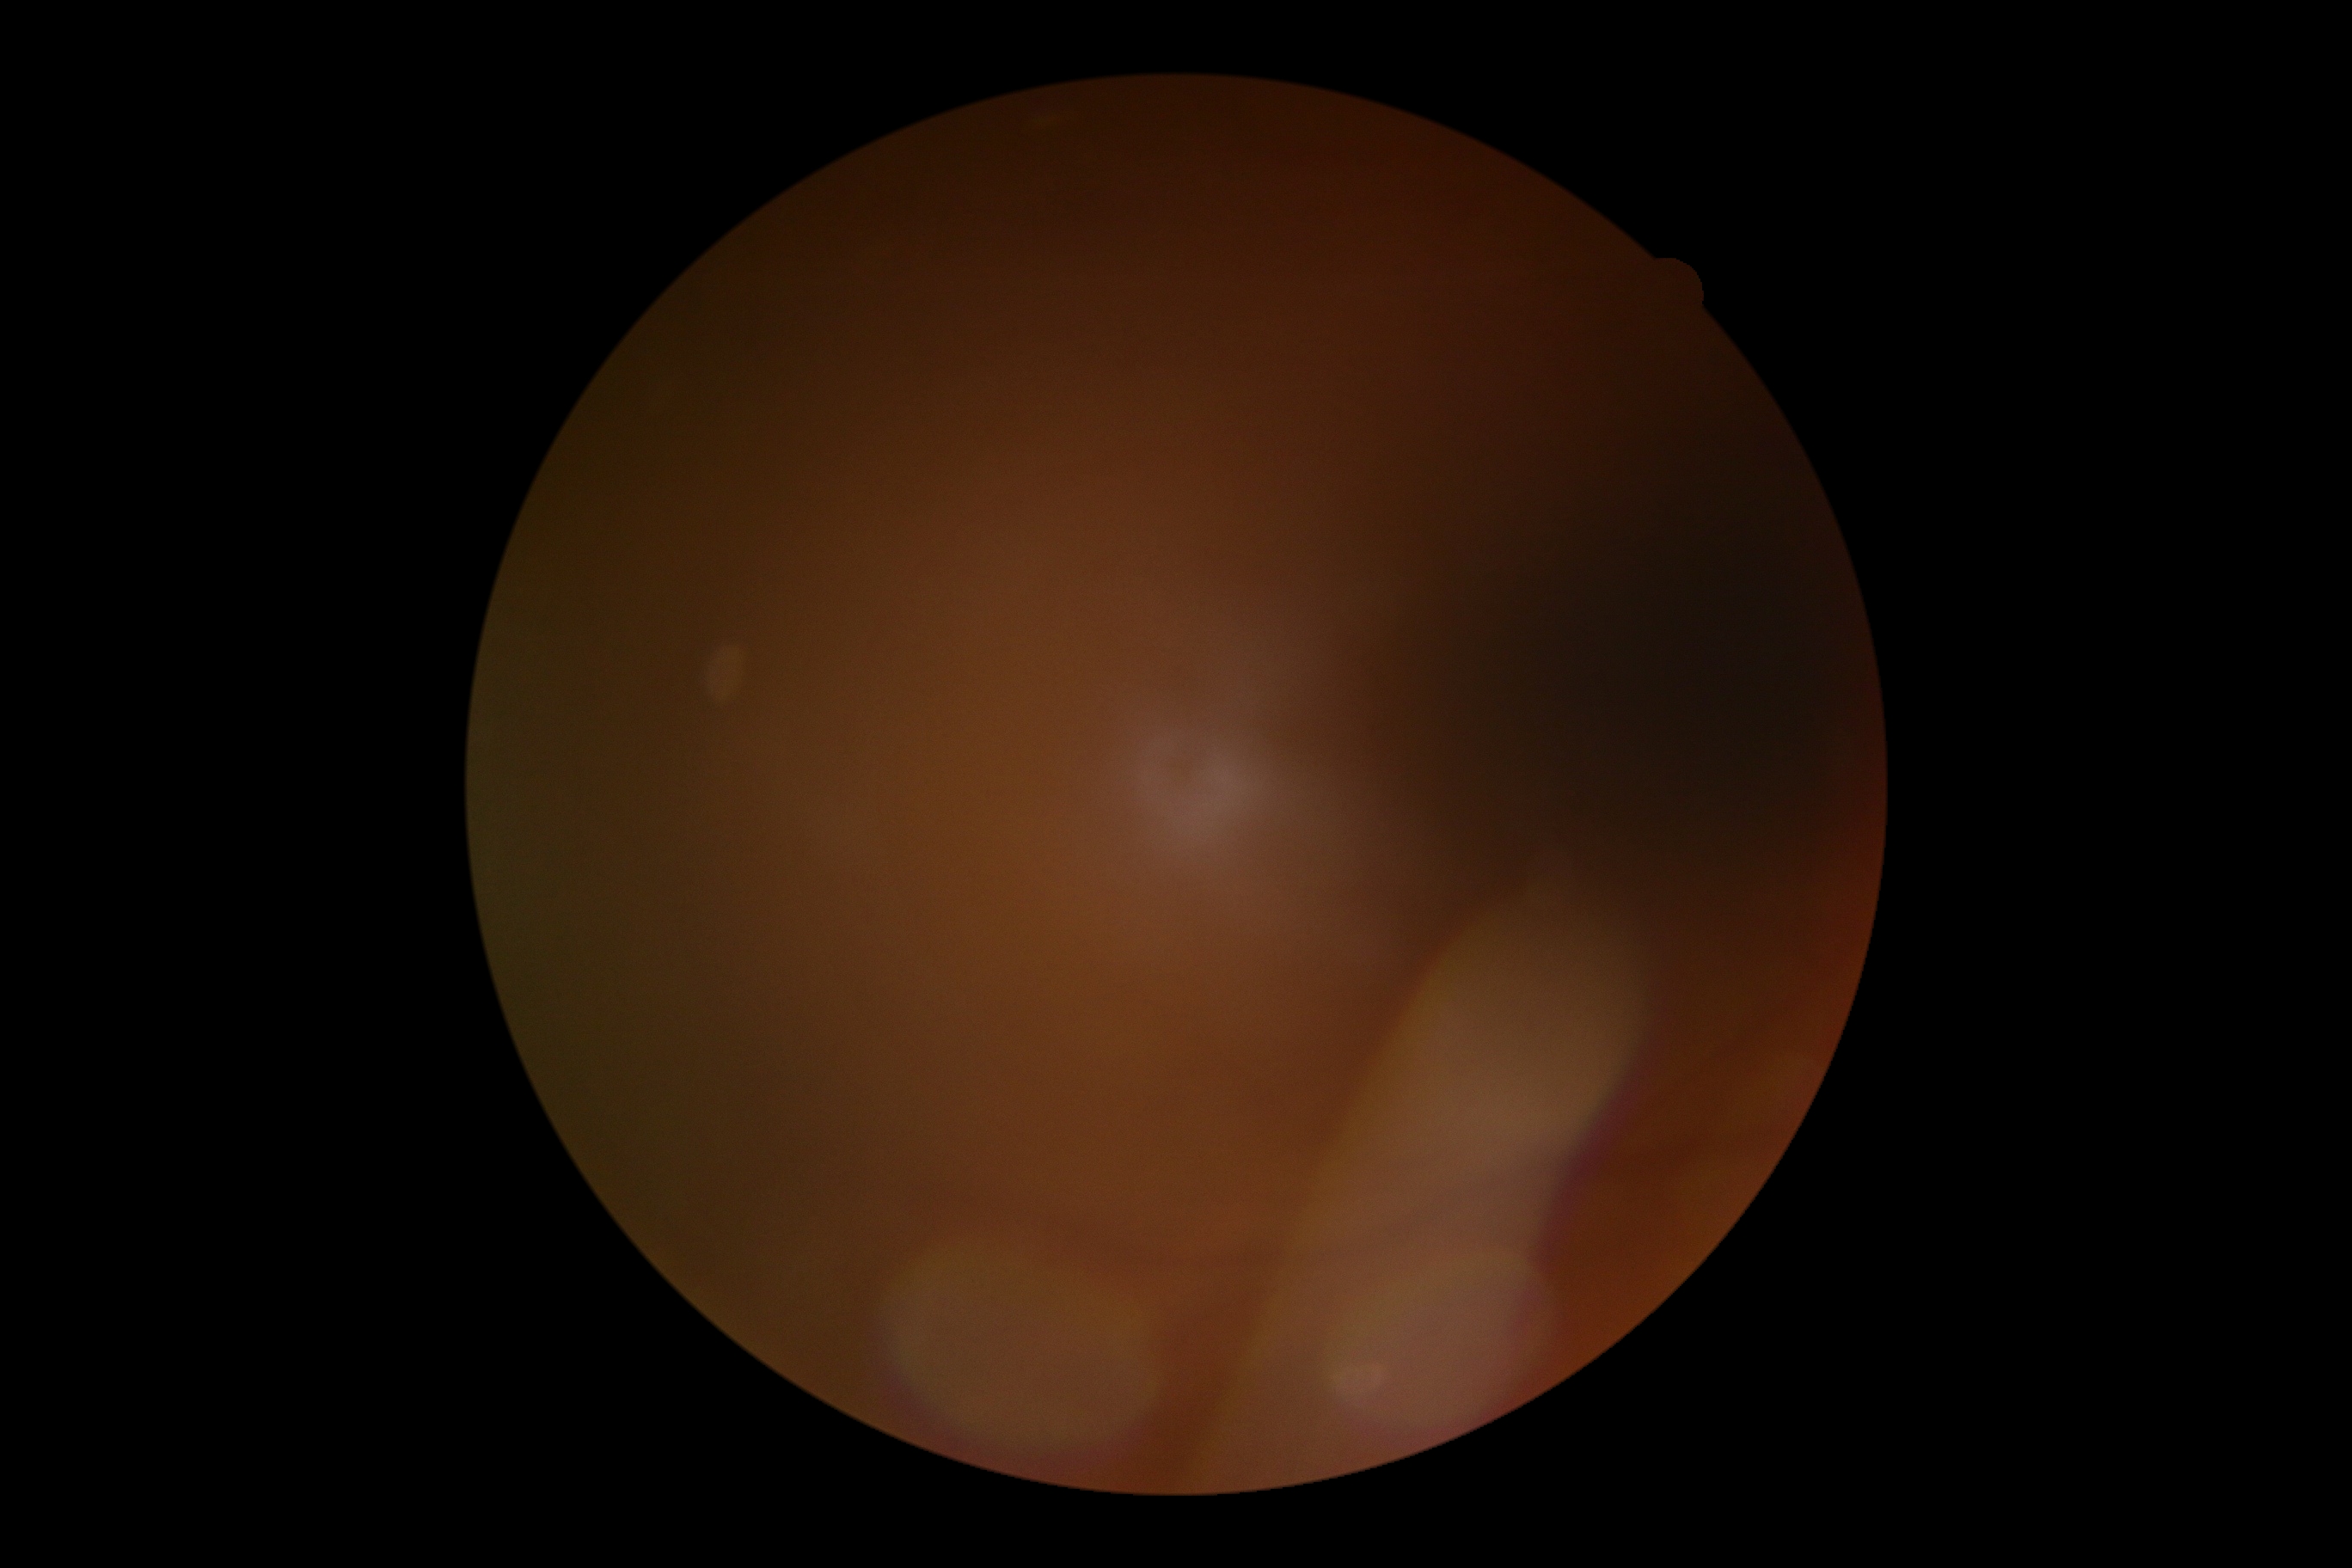 image quality@too poor for DR grading; retinopathy grade@ungradable.